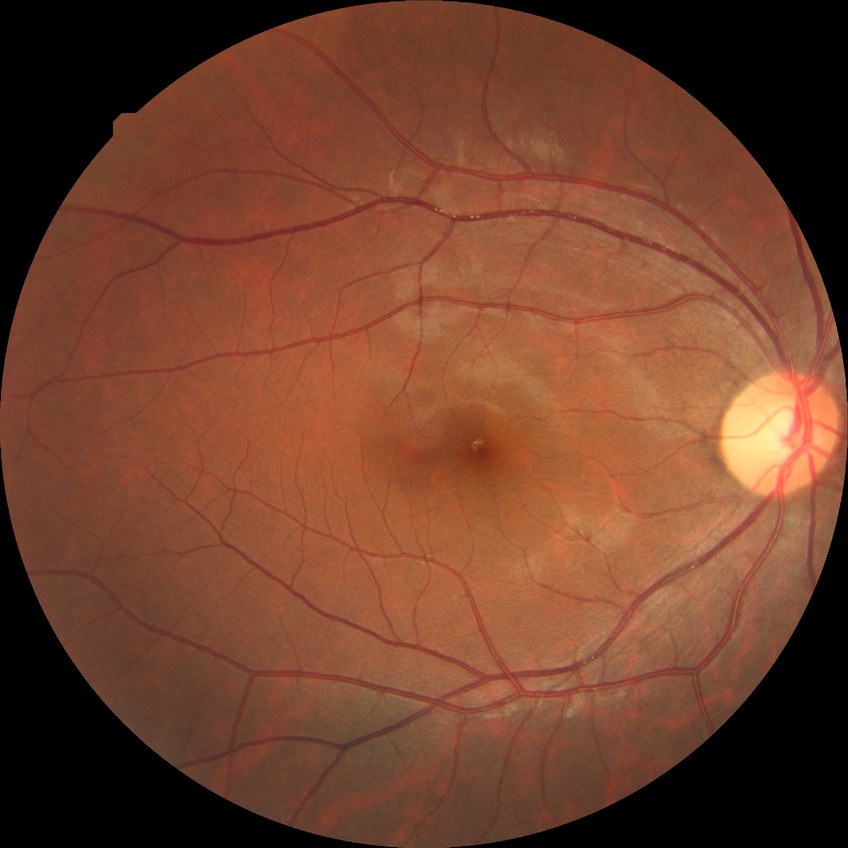
Diabetic retinopathy grade is no diabetic retinopathy.